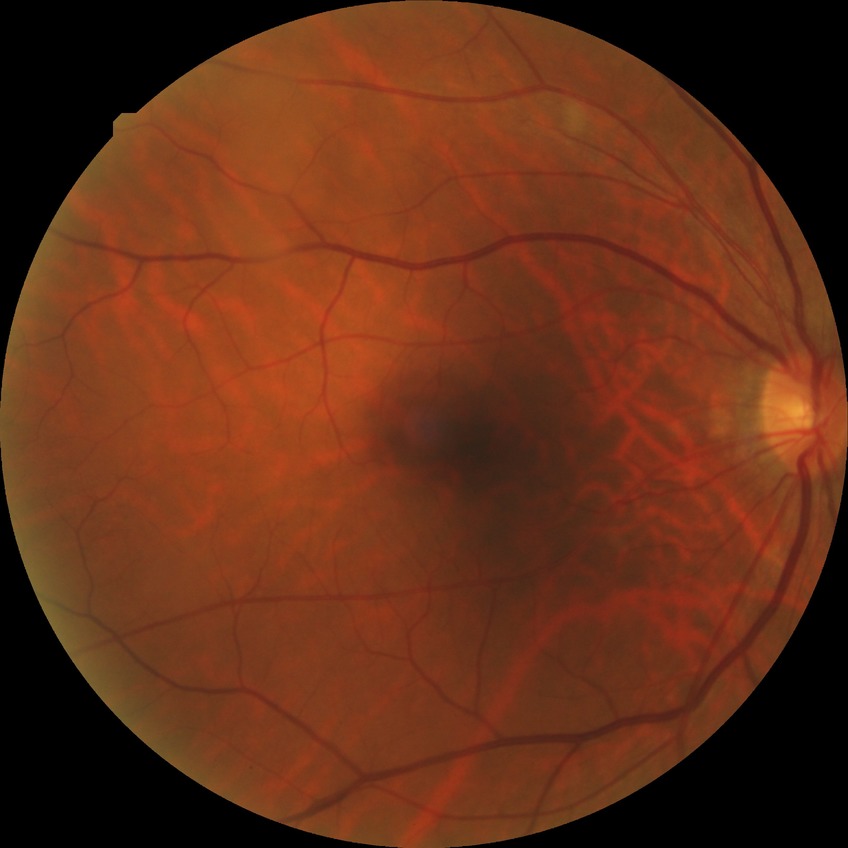

Diabetic retinopathy (DR) is no diabetic retinopathy (NDR).